Image size 2089x1764. Retinal fundus photograph.
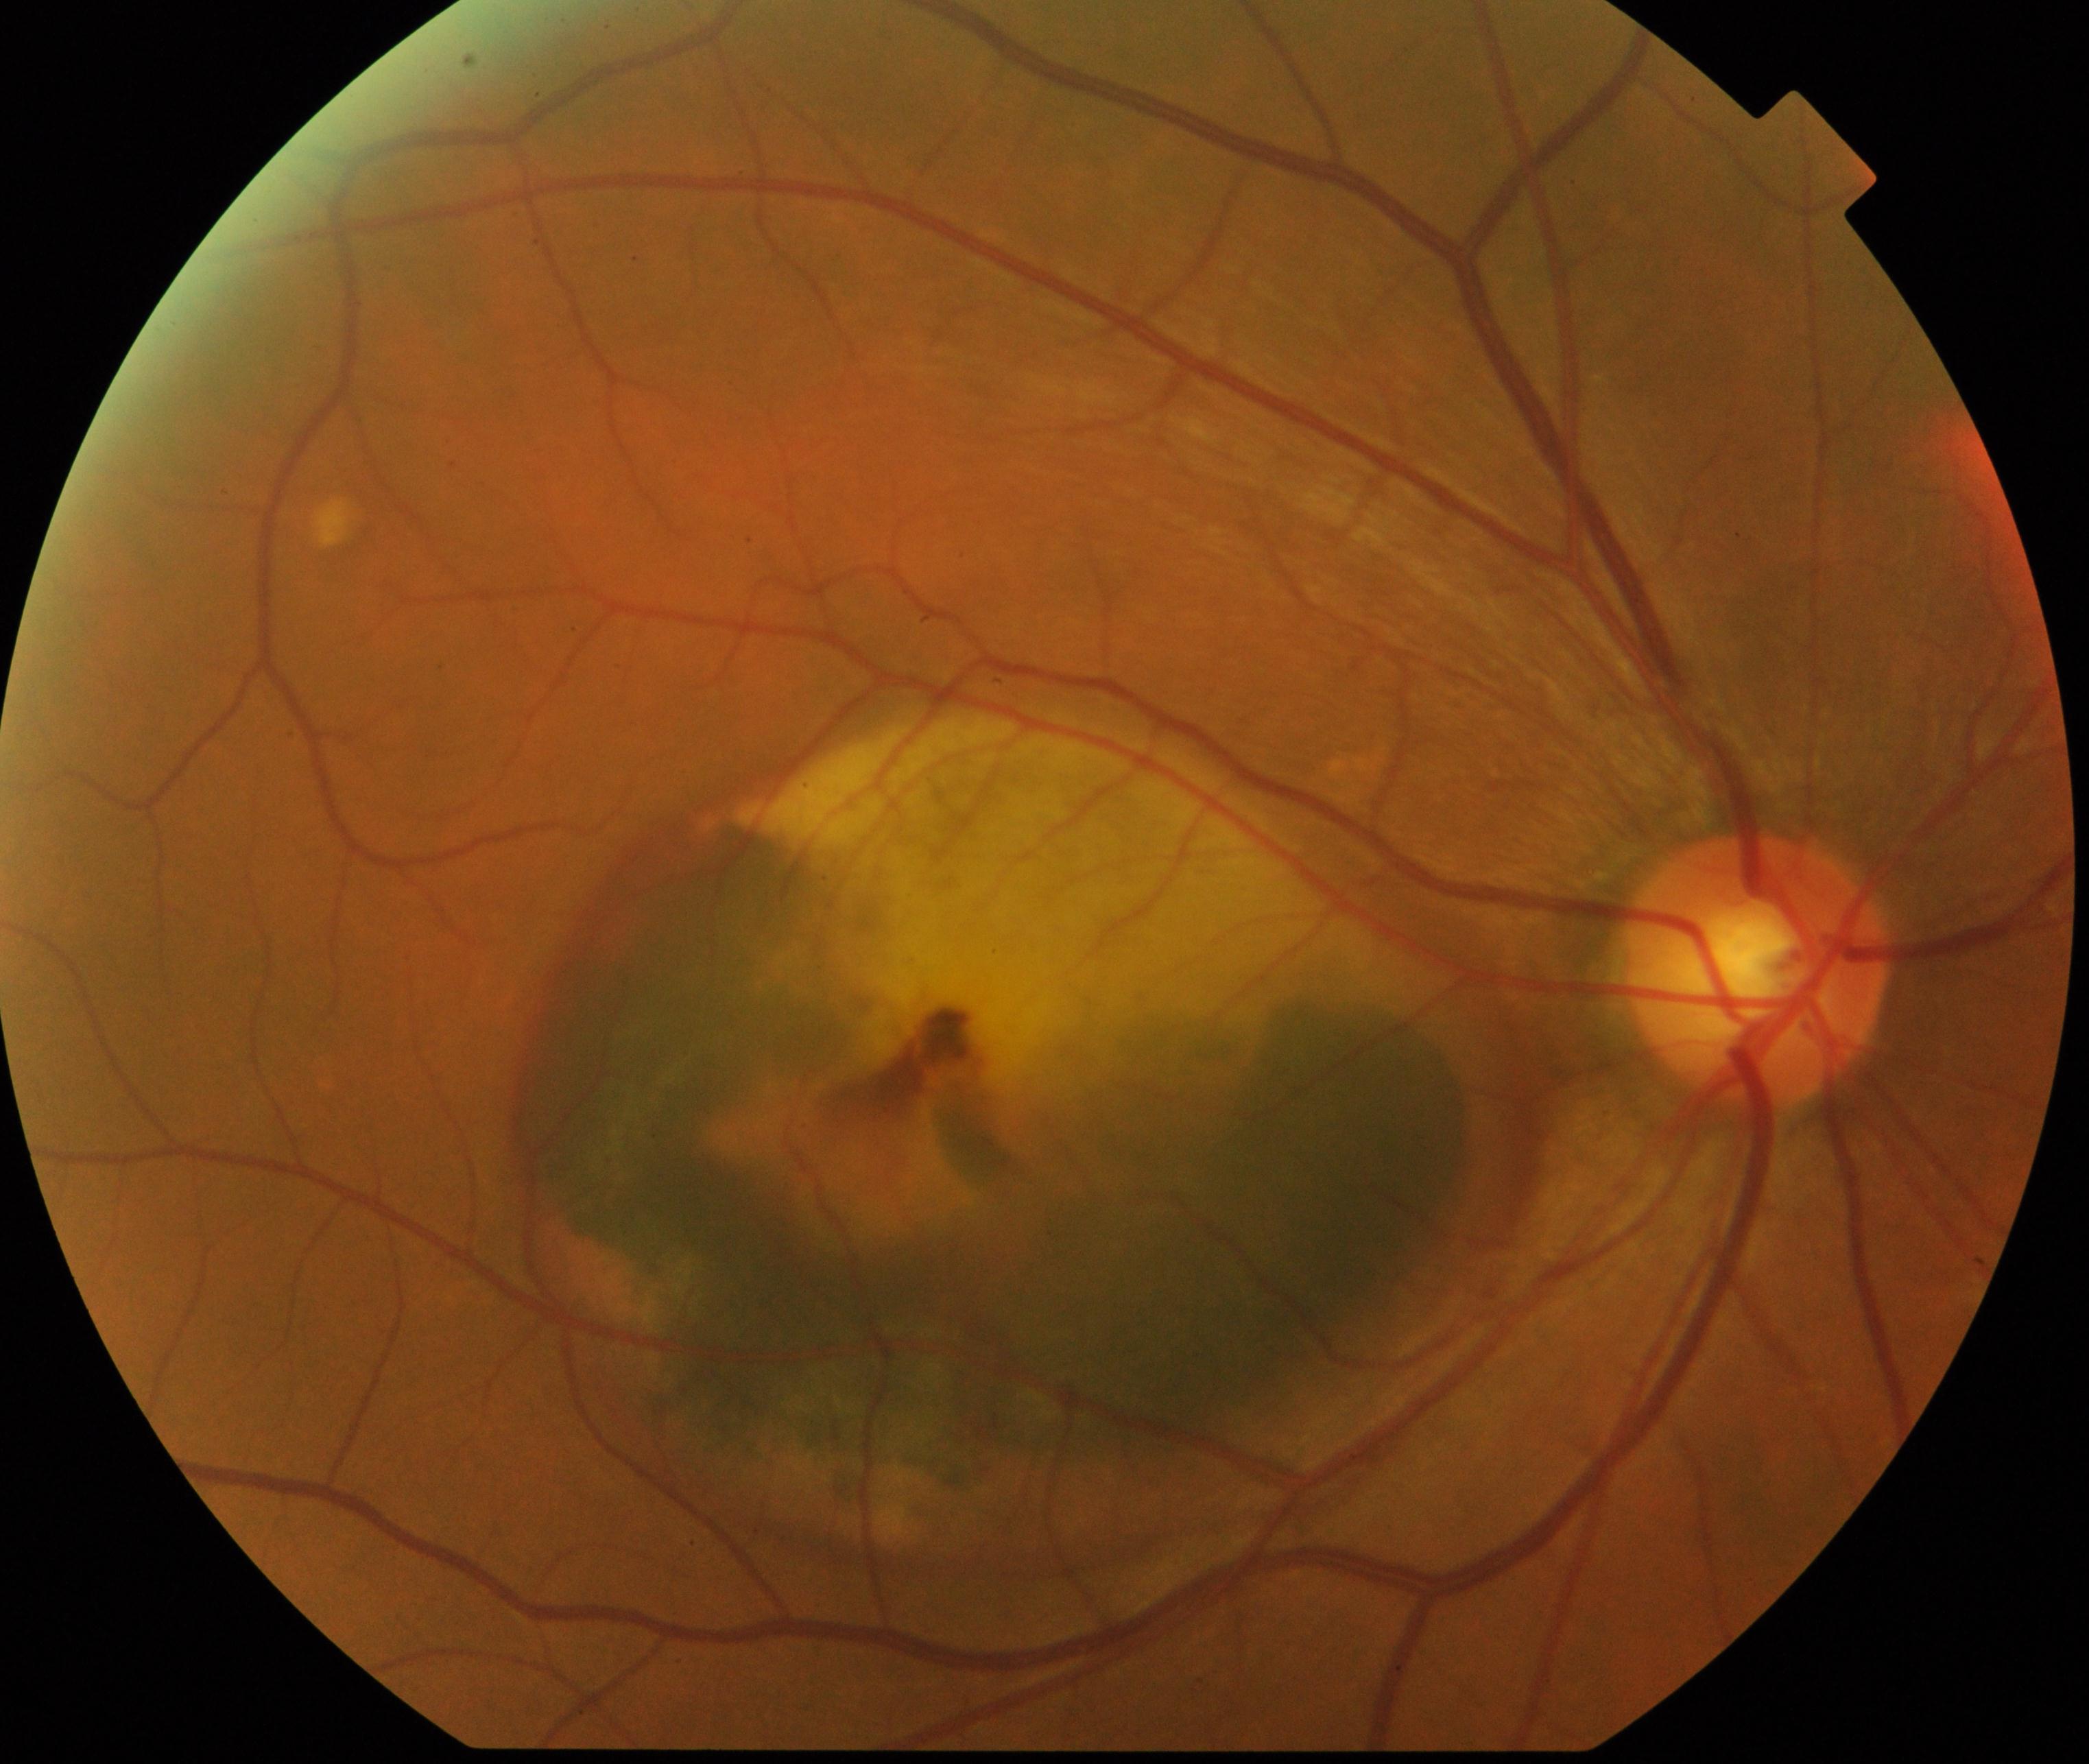
Classification: maculopathy.